Retinal fundus photograph · FOV: 45 degrees: 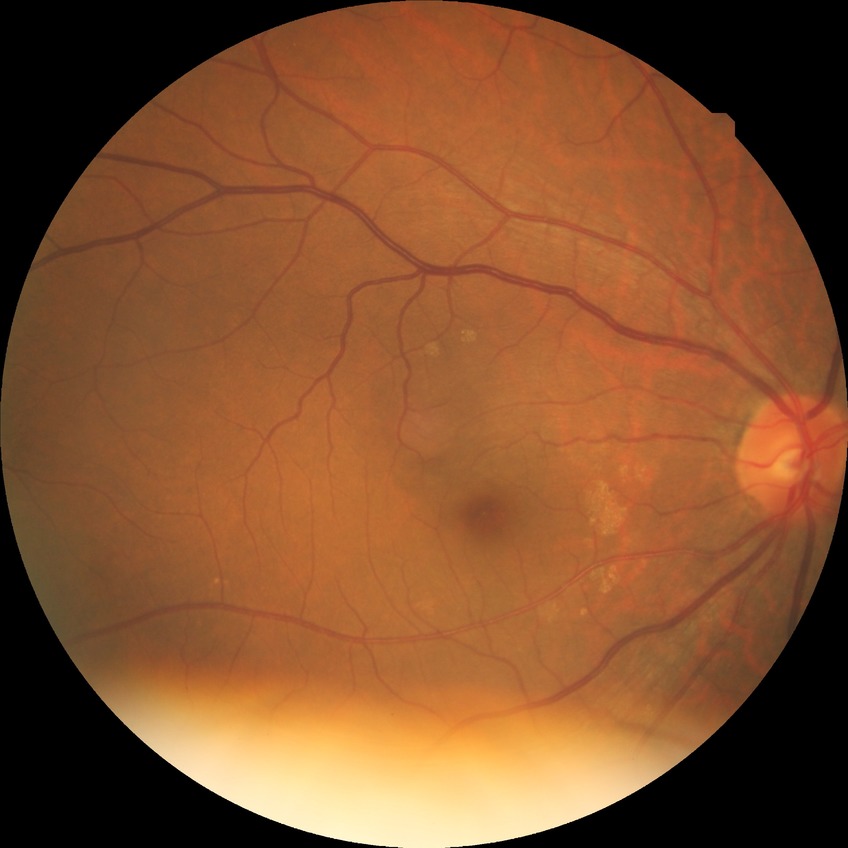 Diabetic retinopathy stage is no diabetic retinopathy.